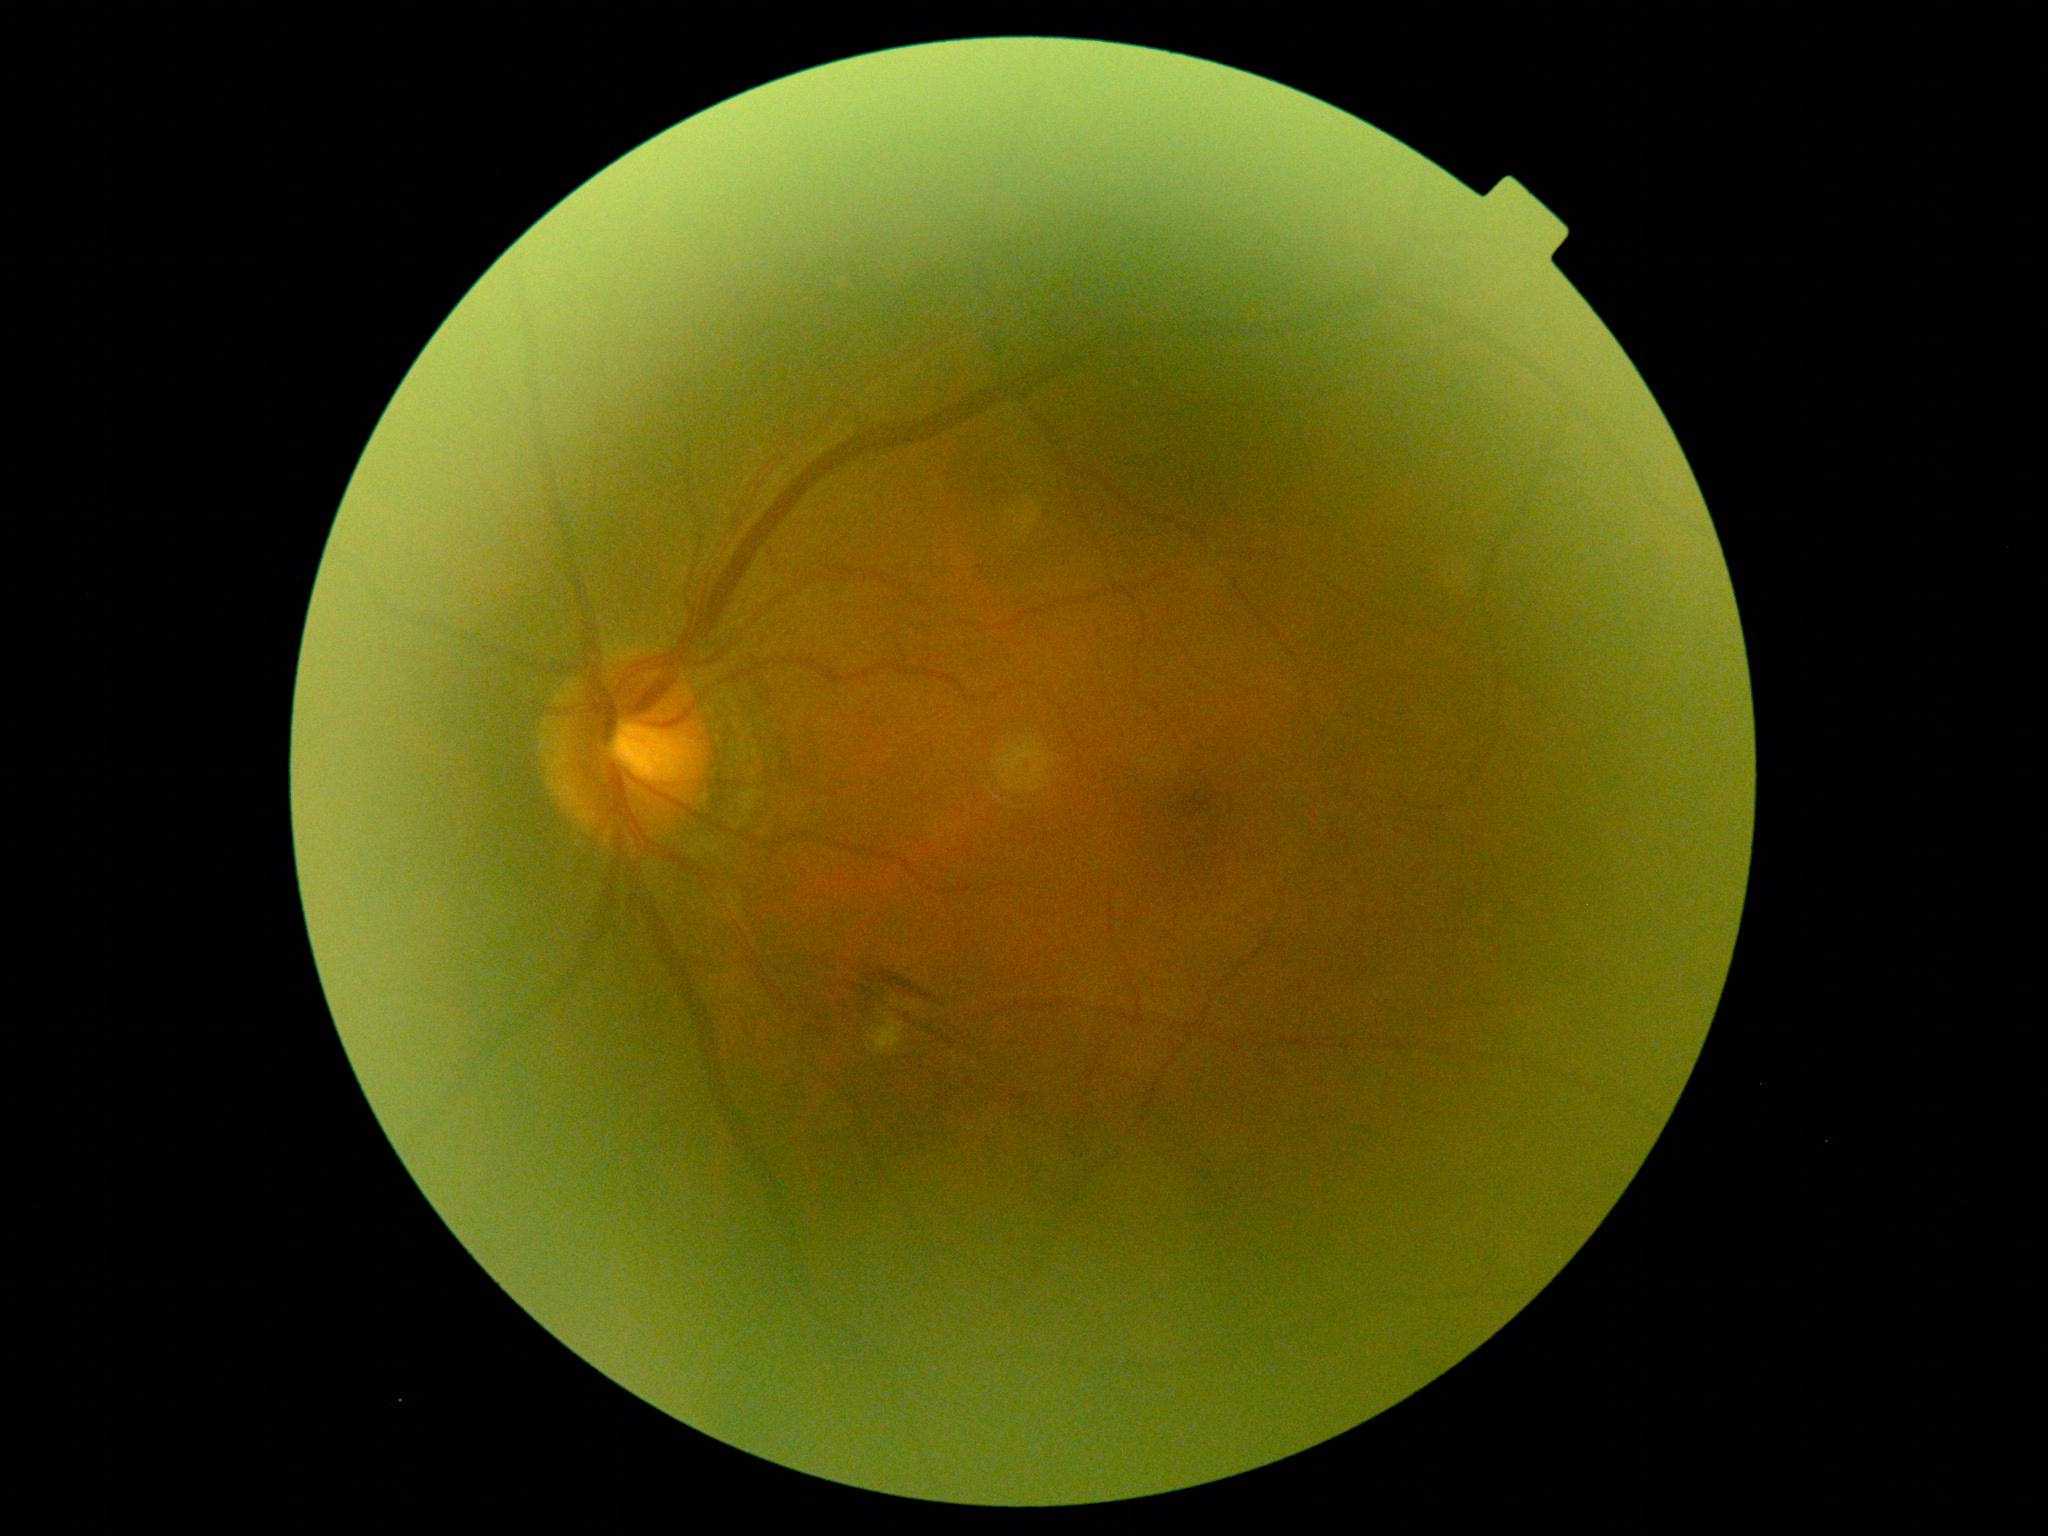

DR stage is grade 2 — more than just microaneurysms but less than severe NPDR.